Acquired with a Topcon TRC-NW8:
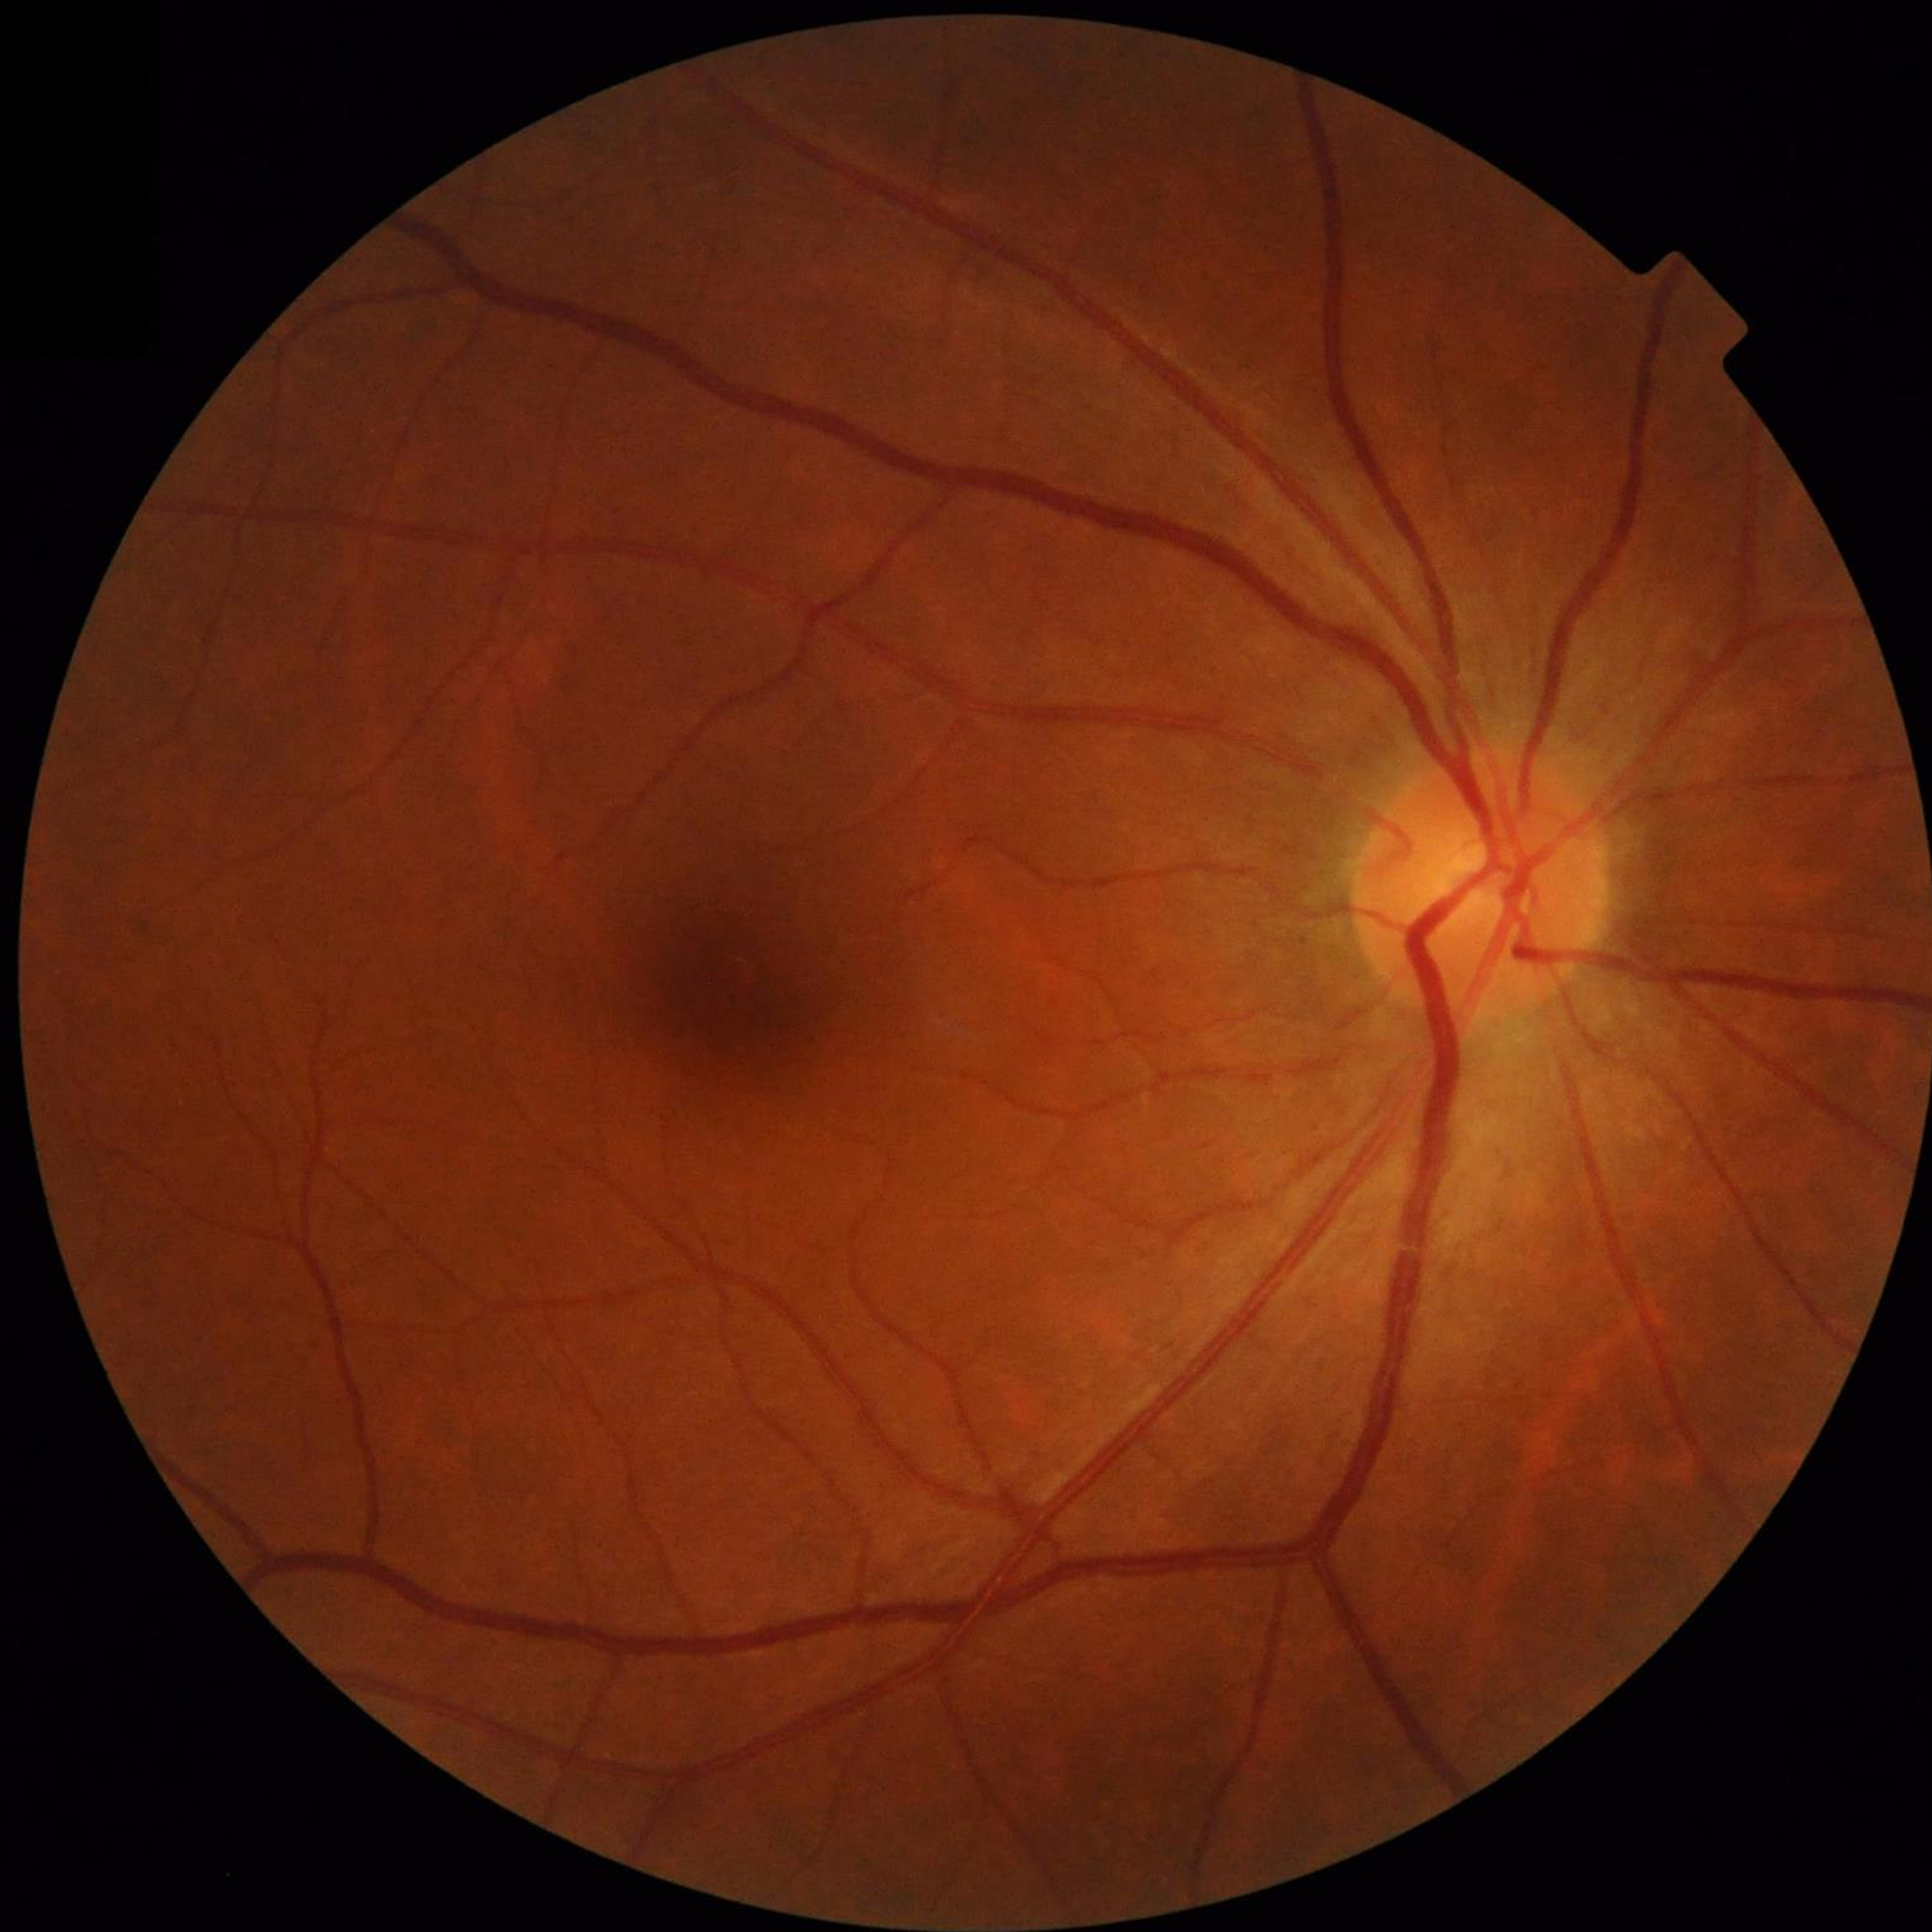 Condition: no AMD, diabetic retinopathy, or glaucoma.